848 by 848 pixels. Acquired with a NIDEK AFC-230
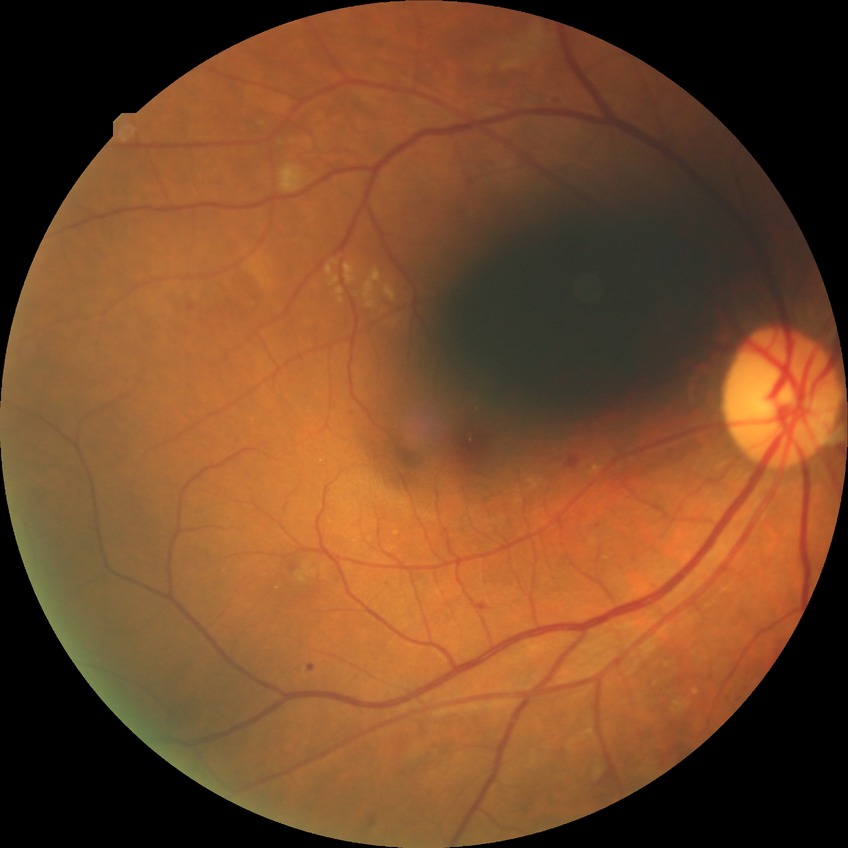

DR class@non-proliferative diabetic retinopathy; modified Davis grade@PPDR.